Acquired with a NIDEK AFC-230; 45-degree field of view; no pharmacologic dilation; CFP — 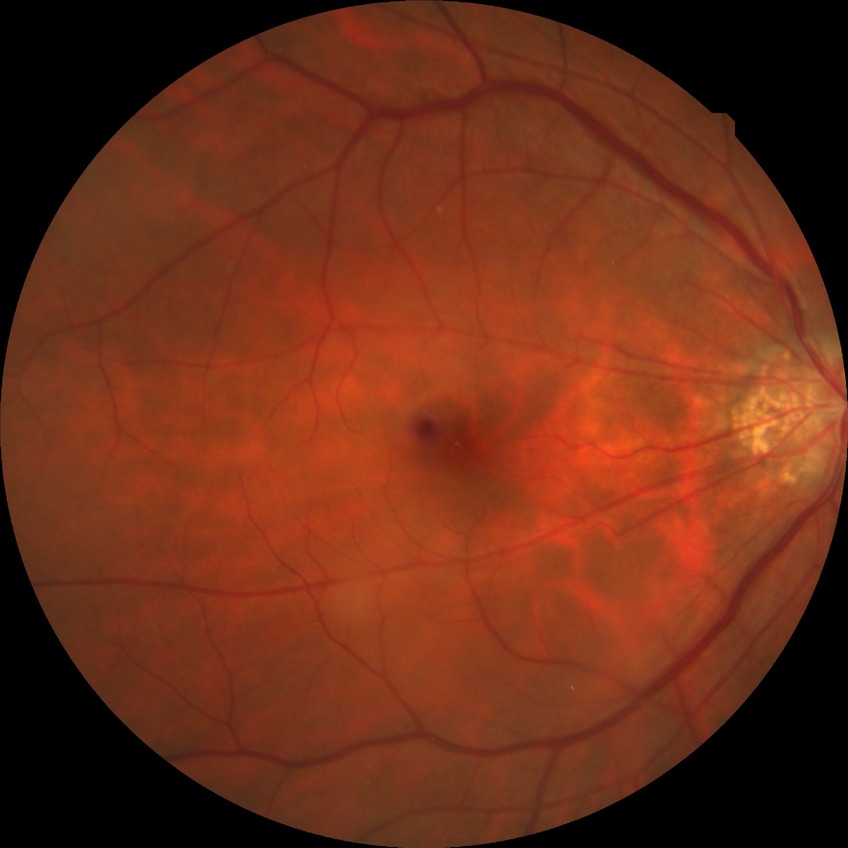

Diabetic retinopathy (DR) is NDR (no diabetic retinopathy).